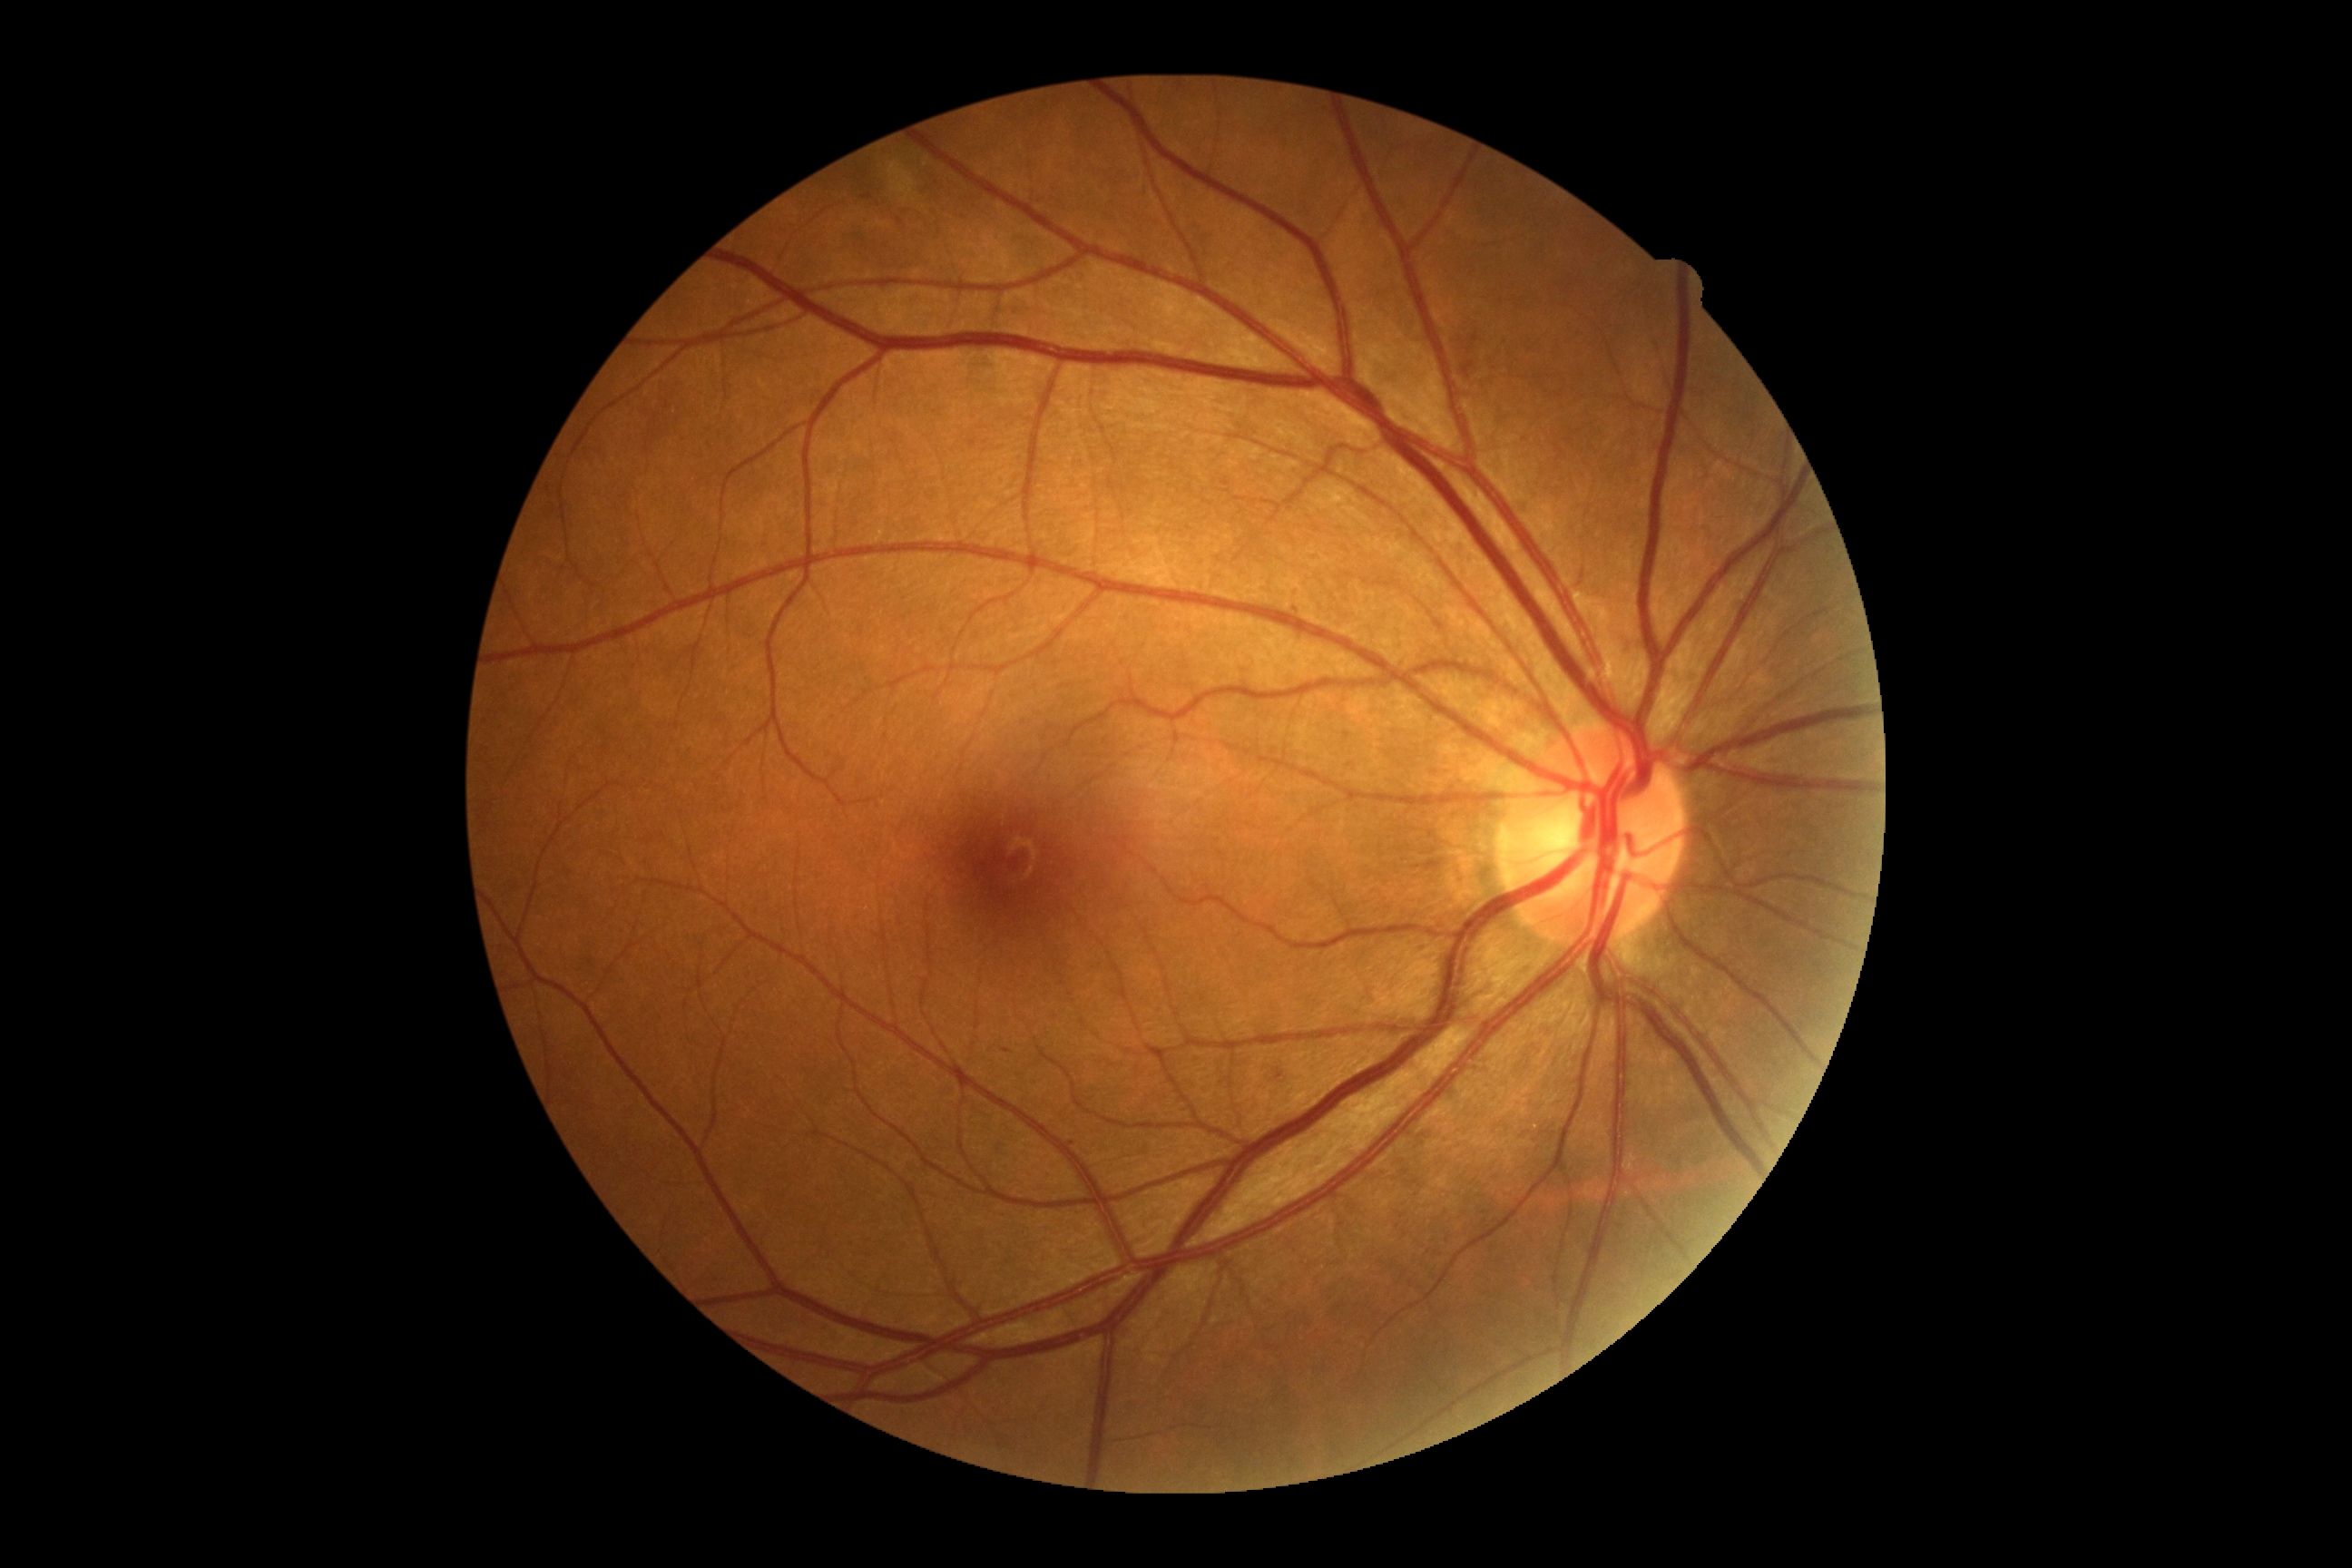

dr_grade: grade 2 (moderate NPDR)